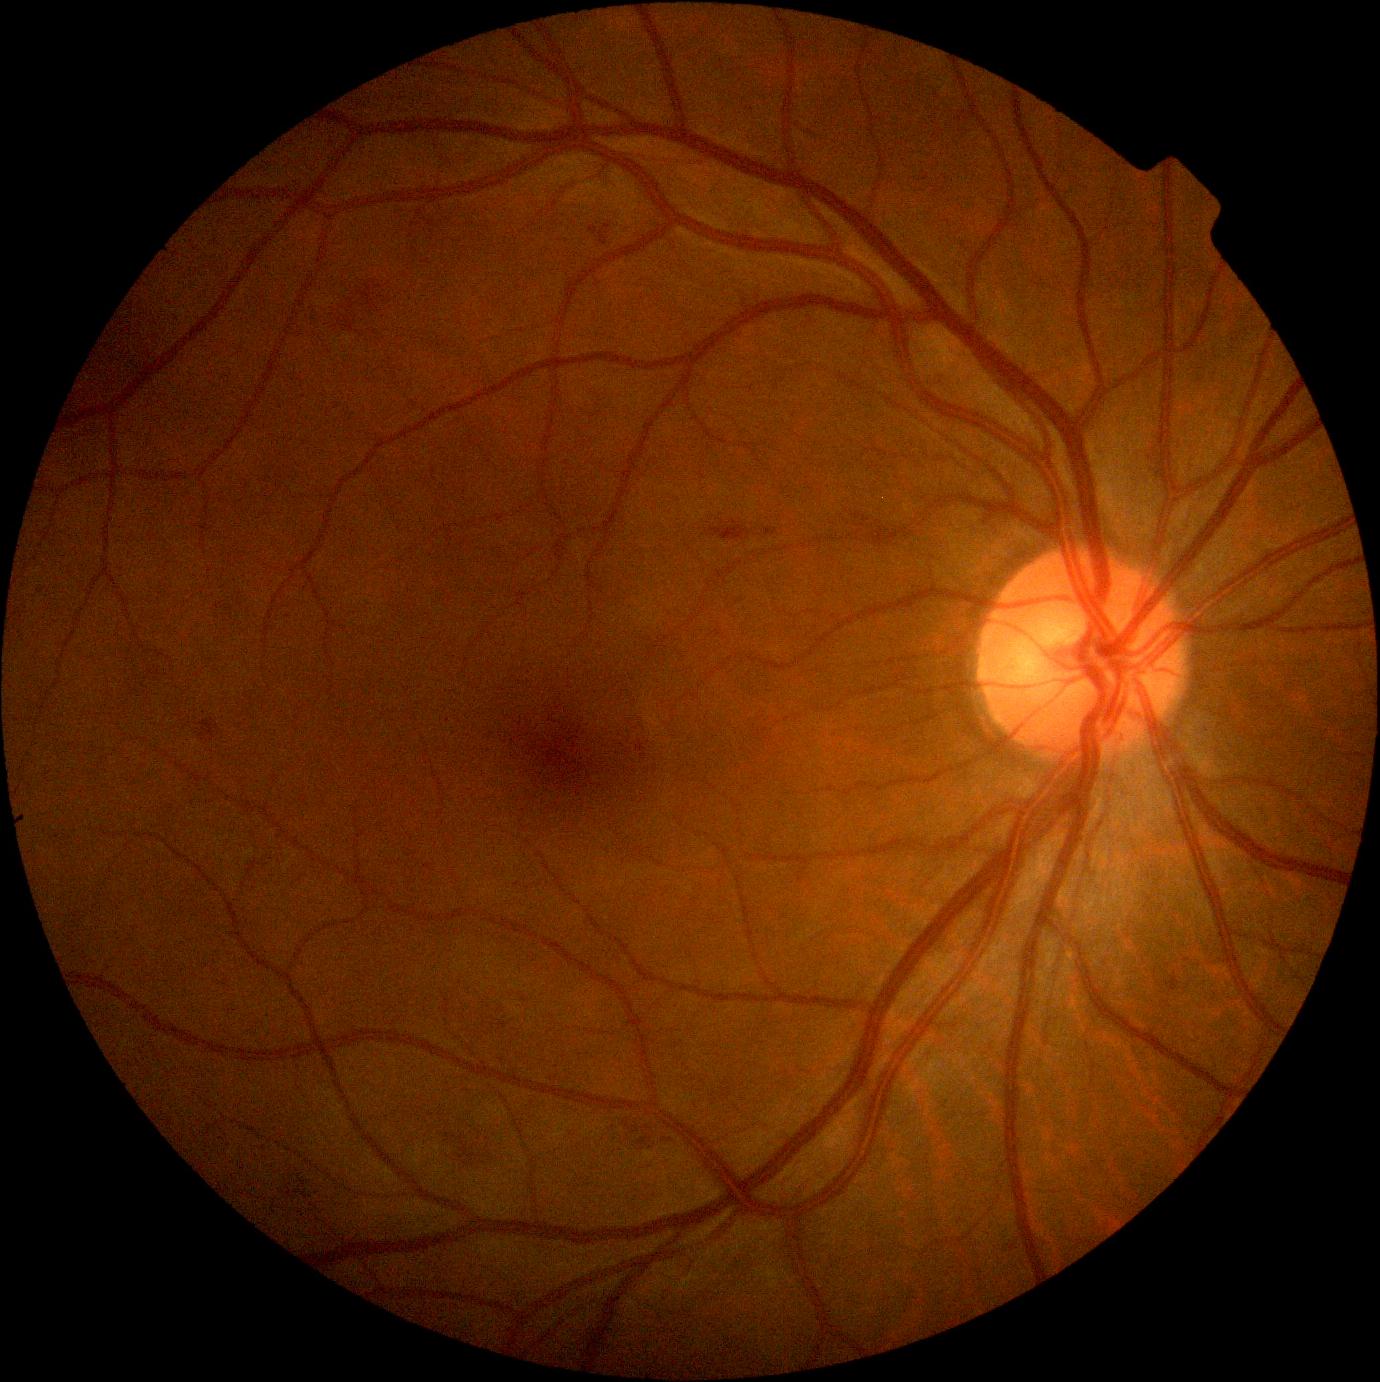
DR stage: 2/4.